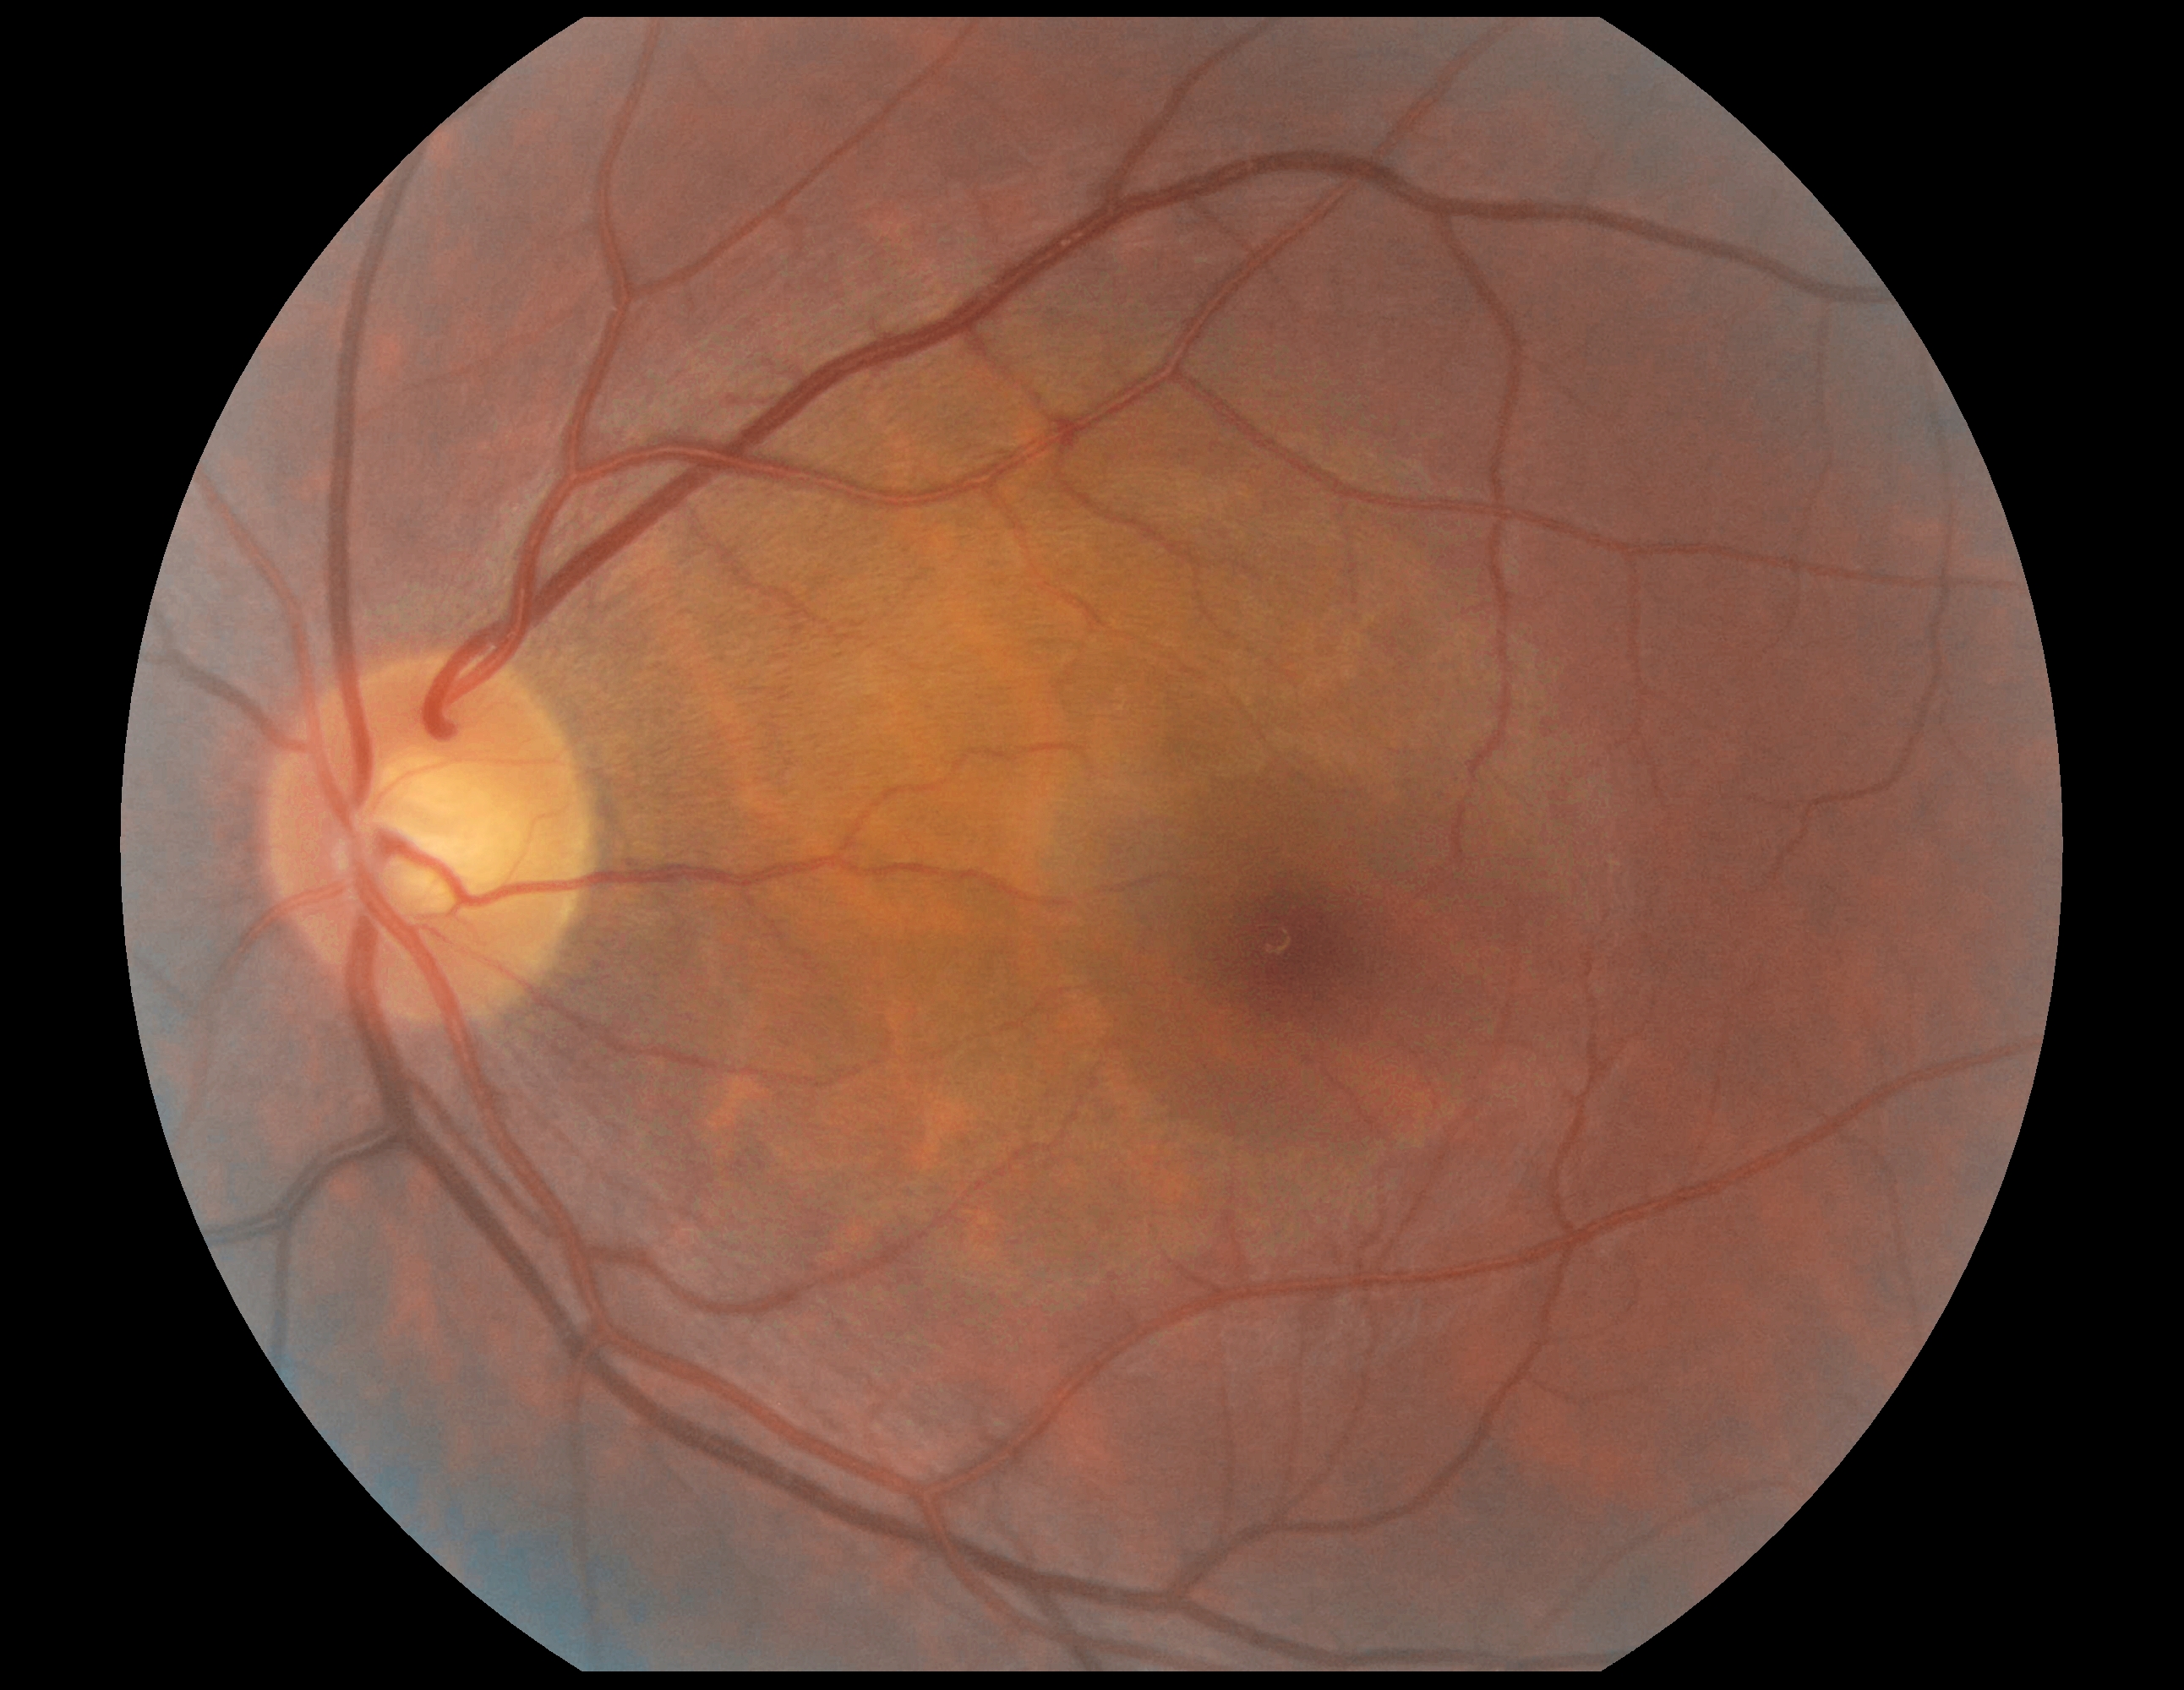
dr_grade: grade 0 (no apparent retinopathy)
dr_impression: no signs of DR